Wide-field fundus image from infant ROP screening. Camera: Natus RetCam Envision (130° FOV).
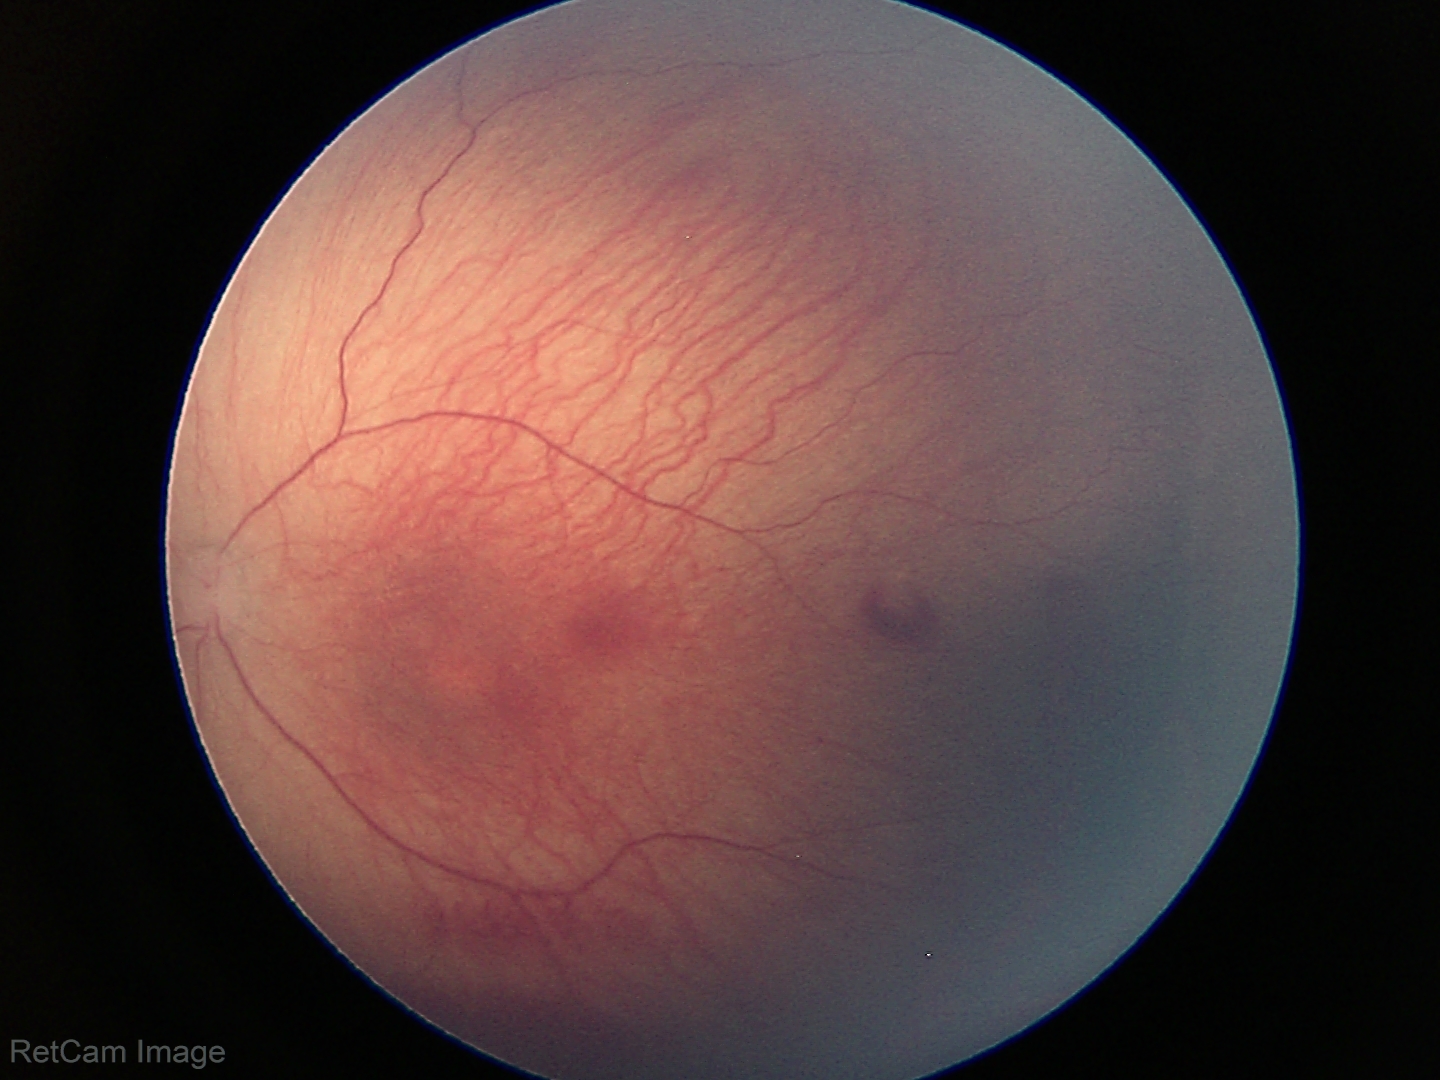 Screening: no plus disease | retinopathy of prematurity stage 1.